2352x1568px — 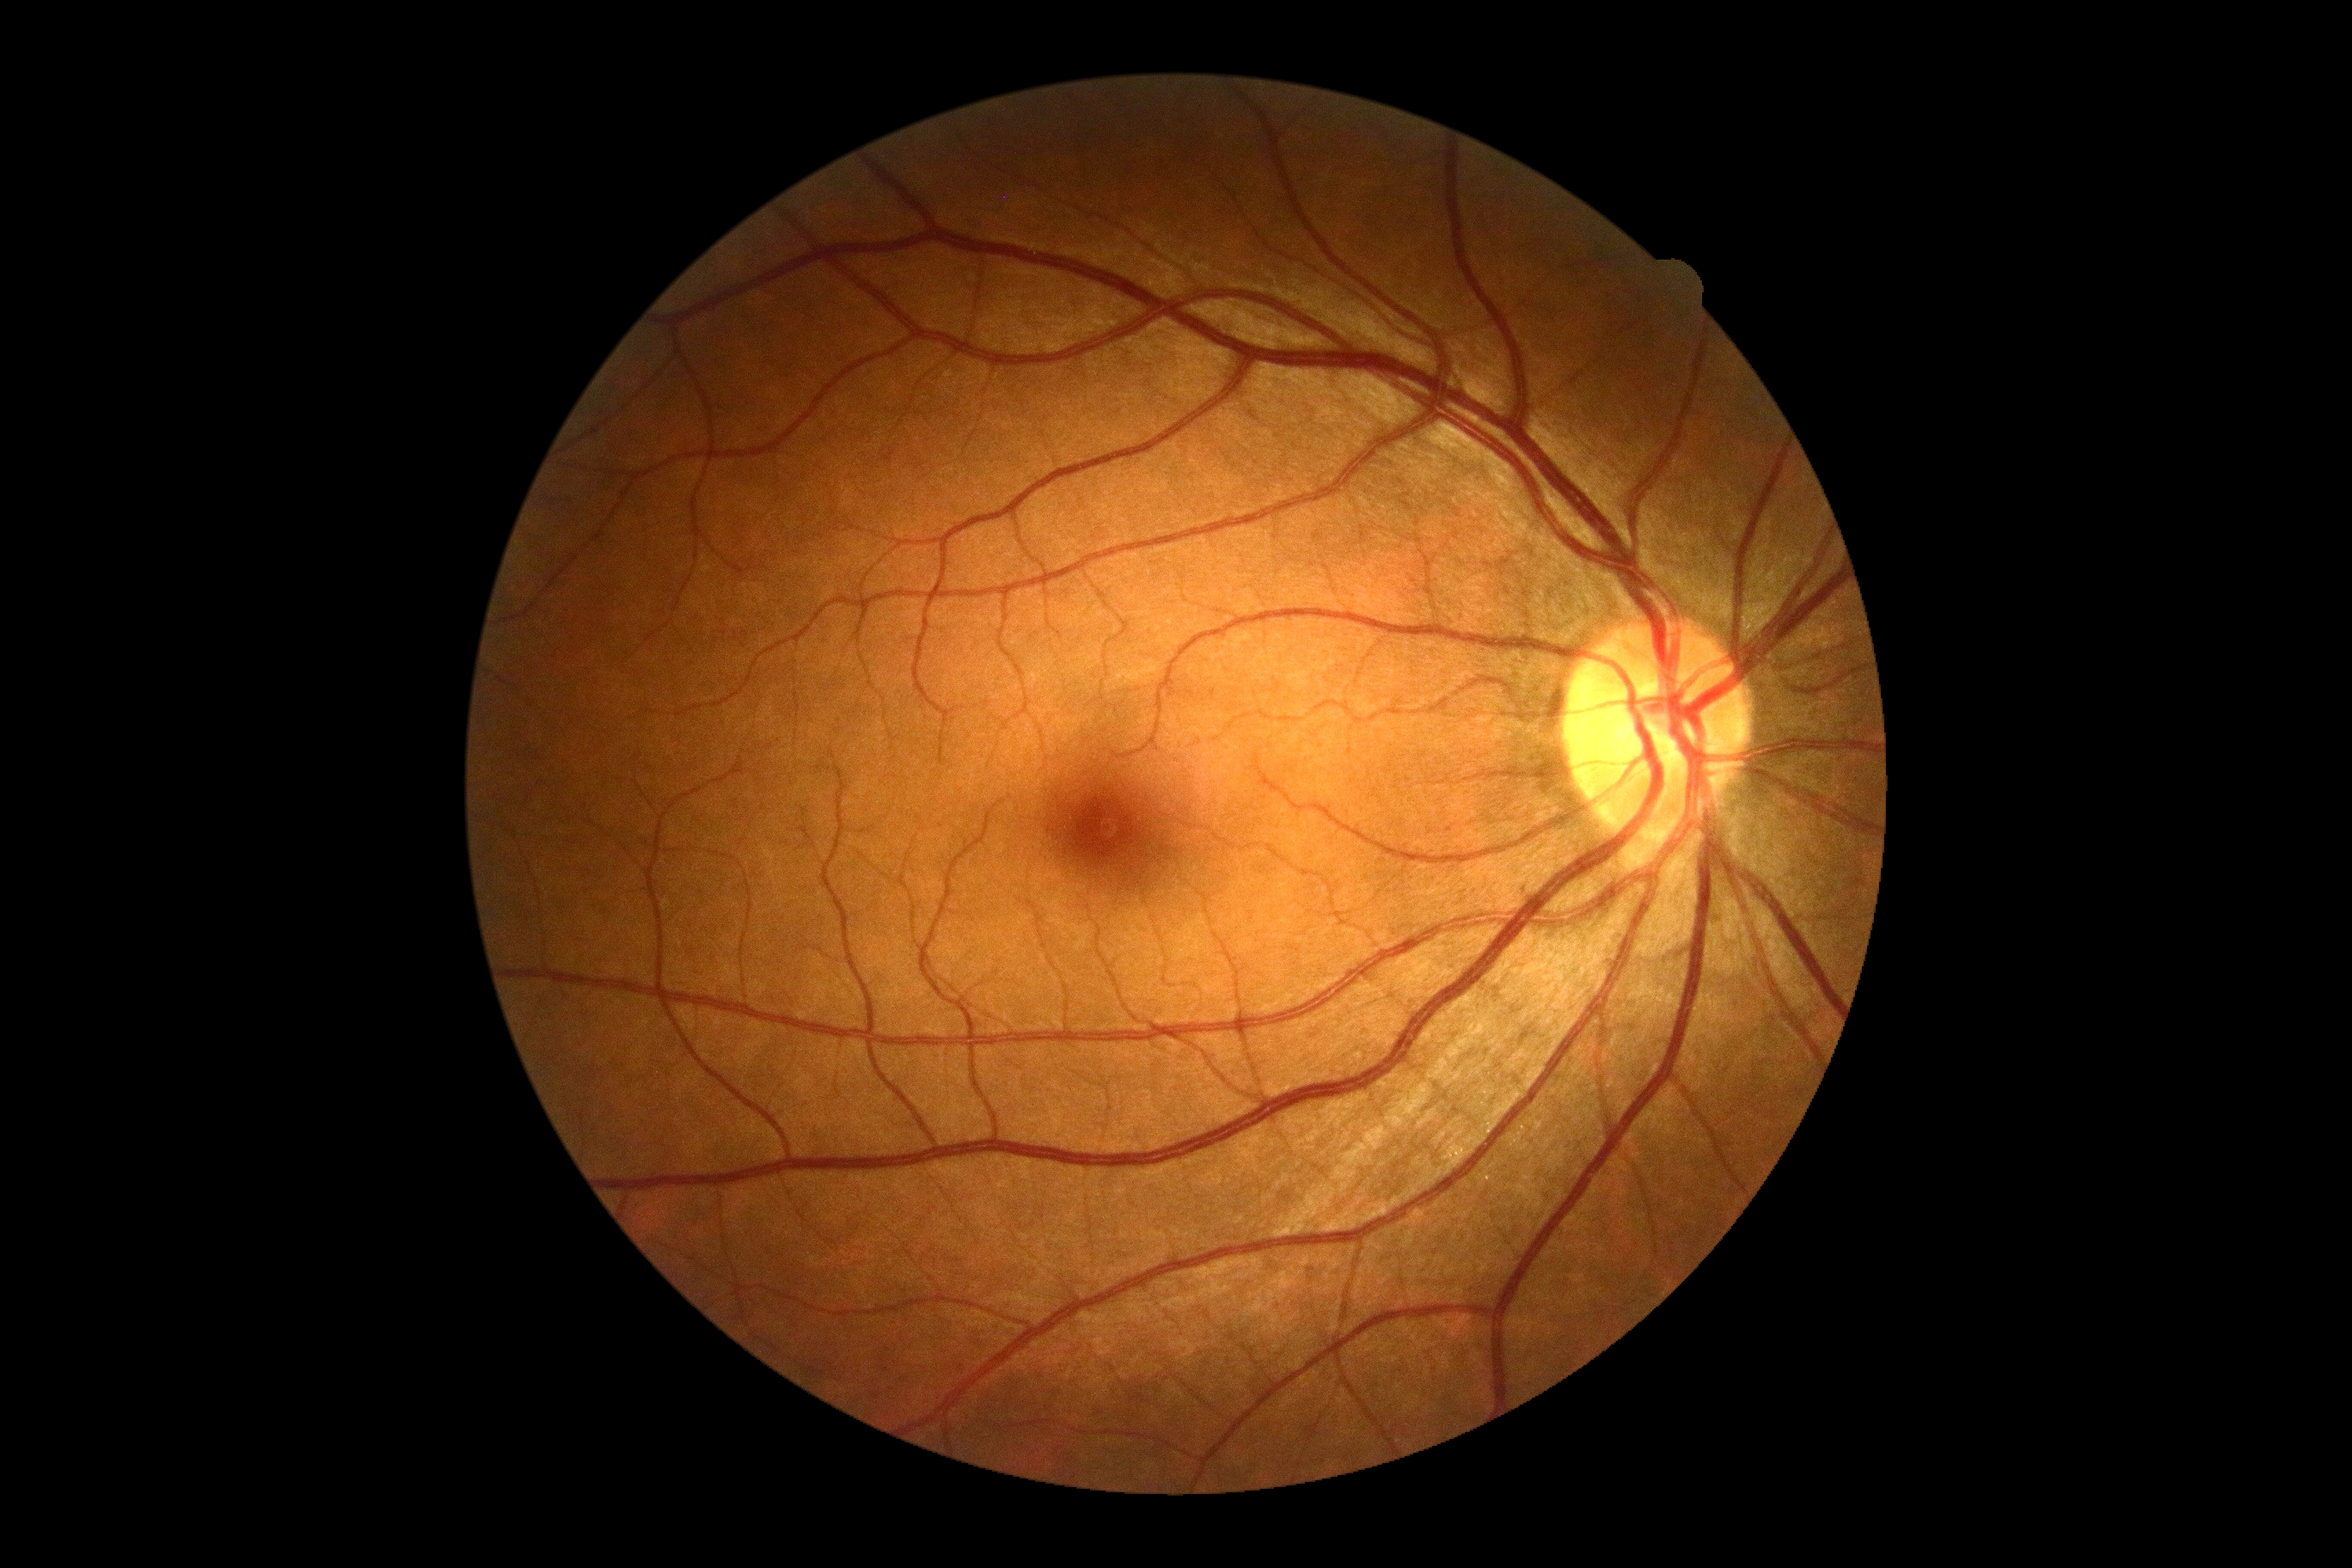 {
  "dr_grade": "0/4"
}